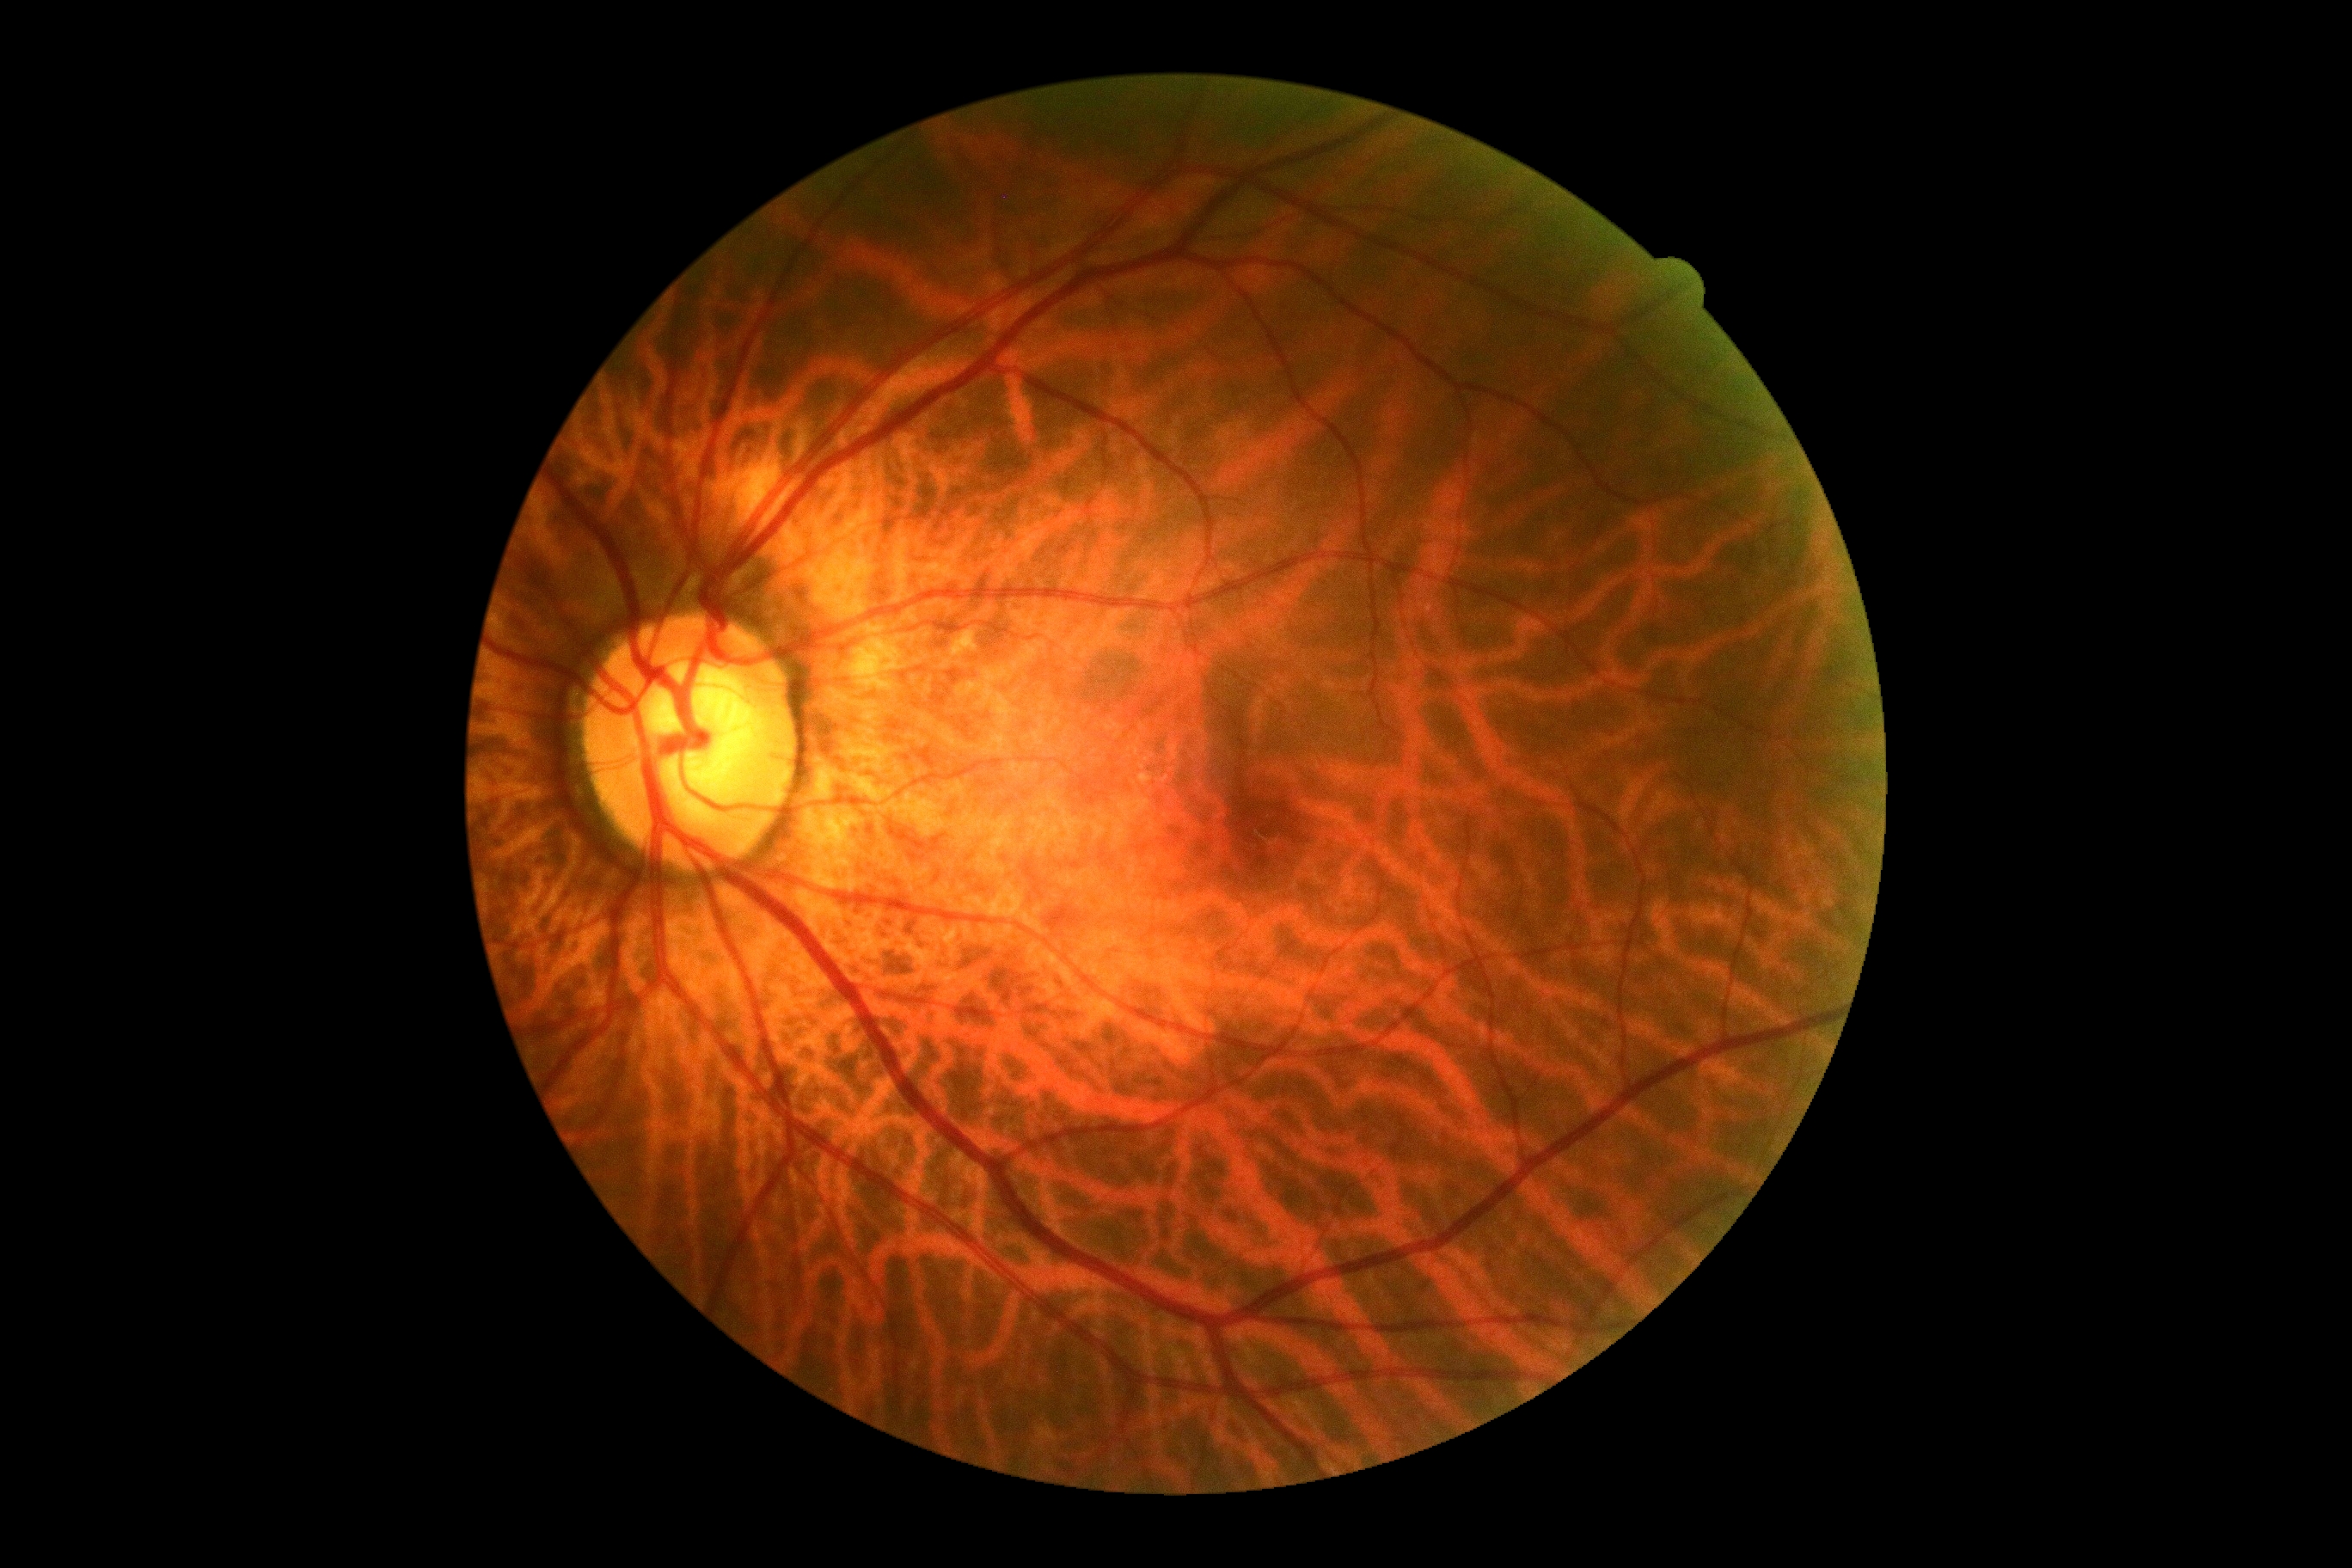
No DR findings.
DR is no apparent diabetic retinopathy (grade 0).